Modified Davis grading, CFP — 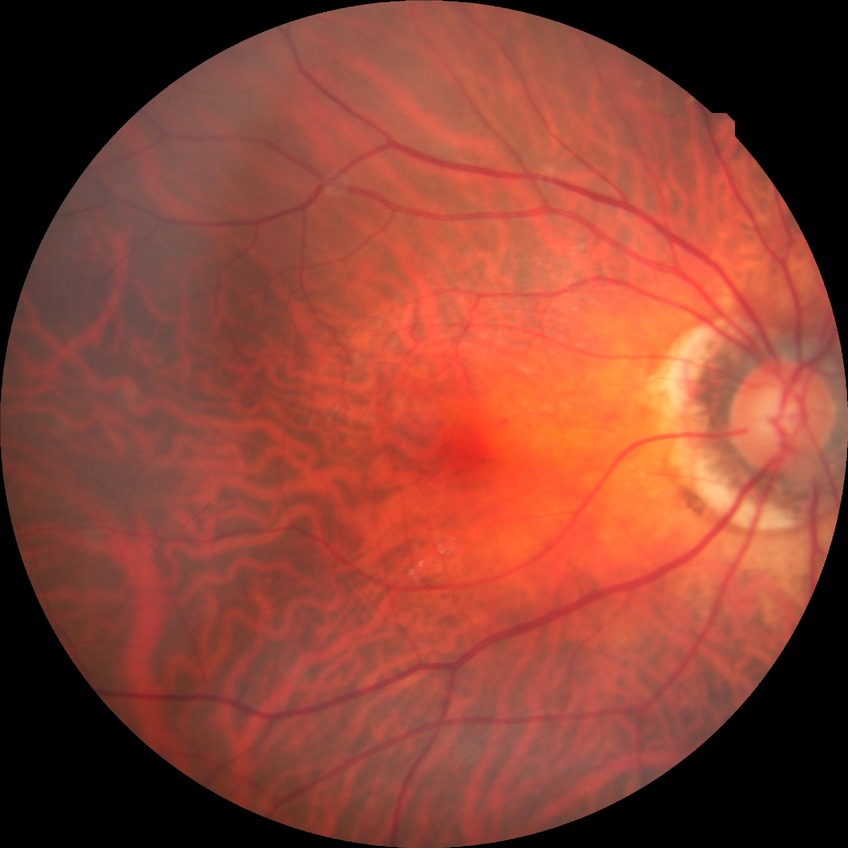

Davis grading: no diabetic retinopathy.